Captured with the Phoenix ICON (100° field of view); wide-field fundus photograph of an infant: 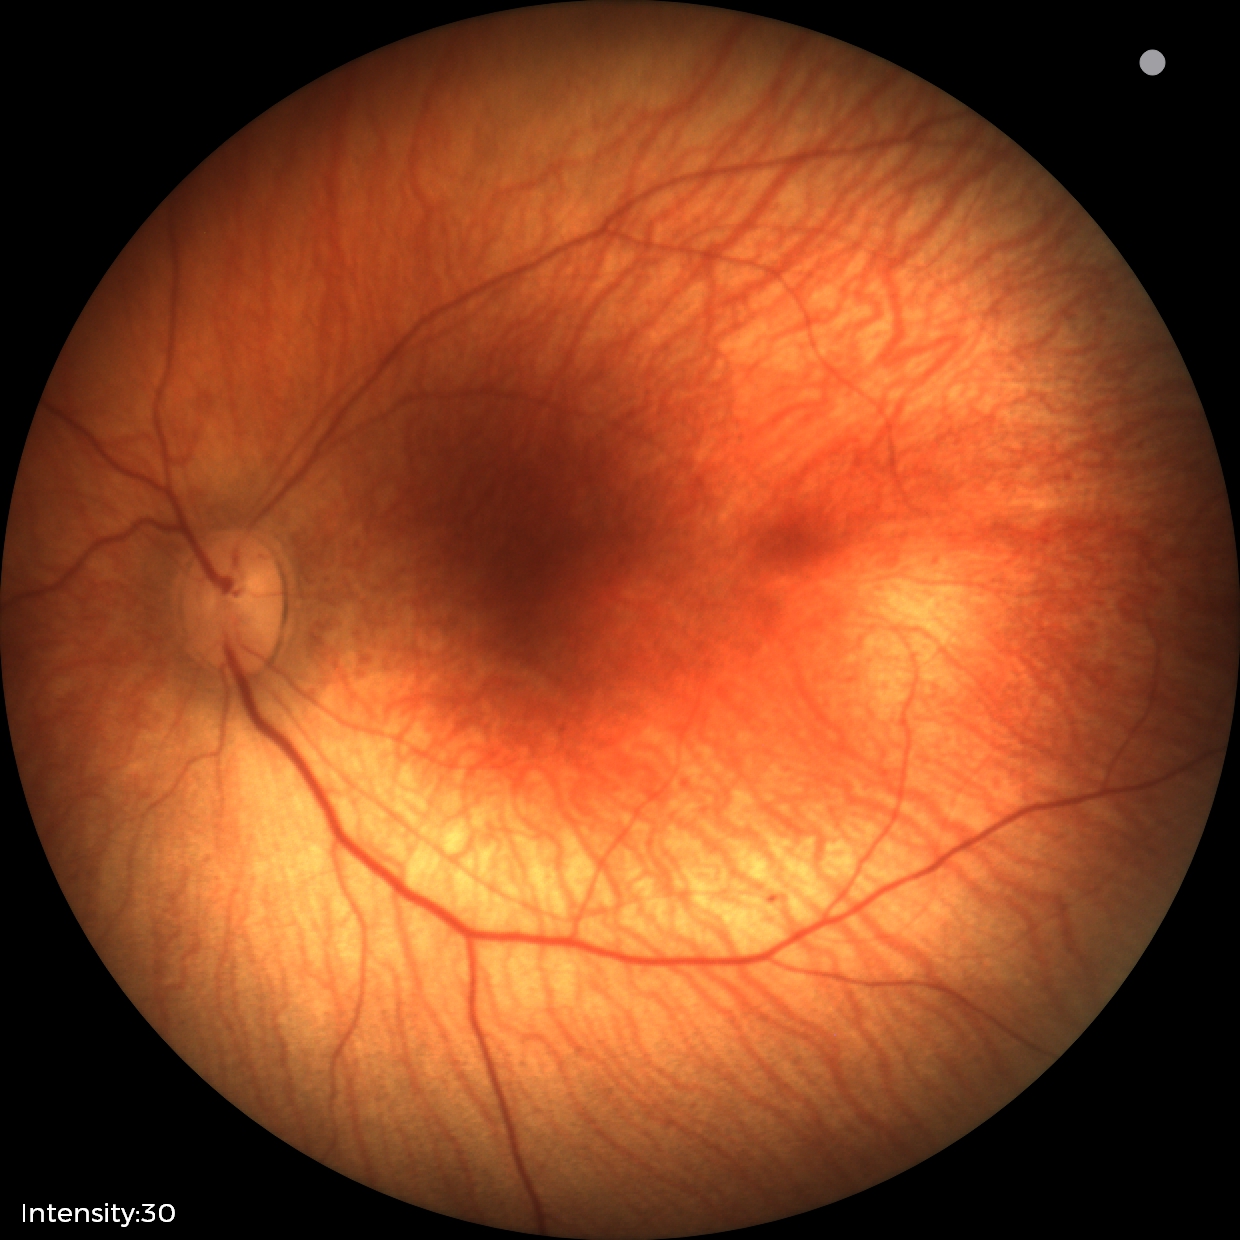

Examination with physiological retinal findings.